FOV: 45 degrees:
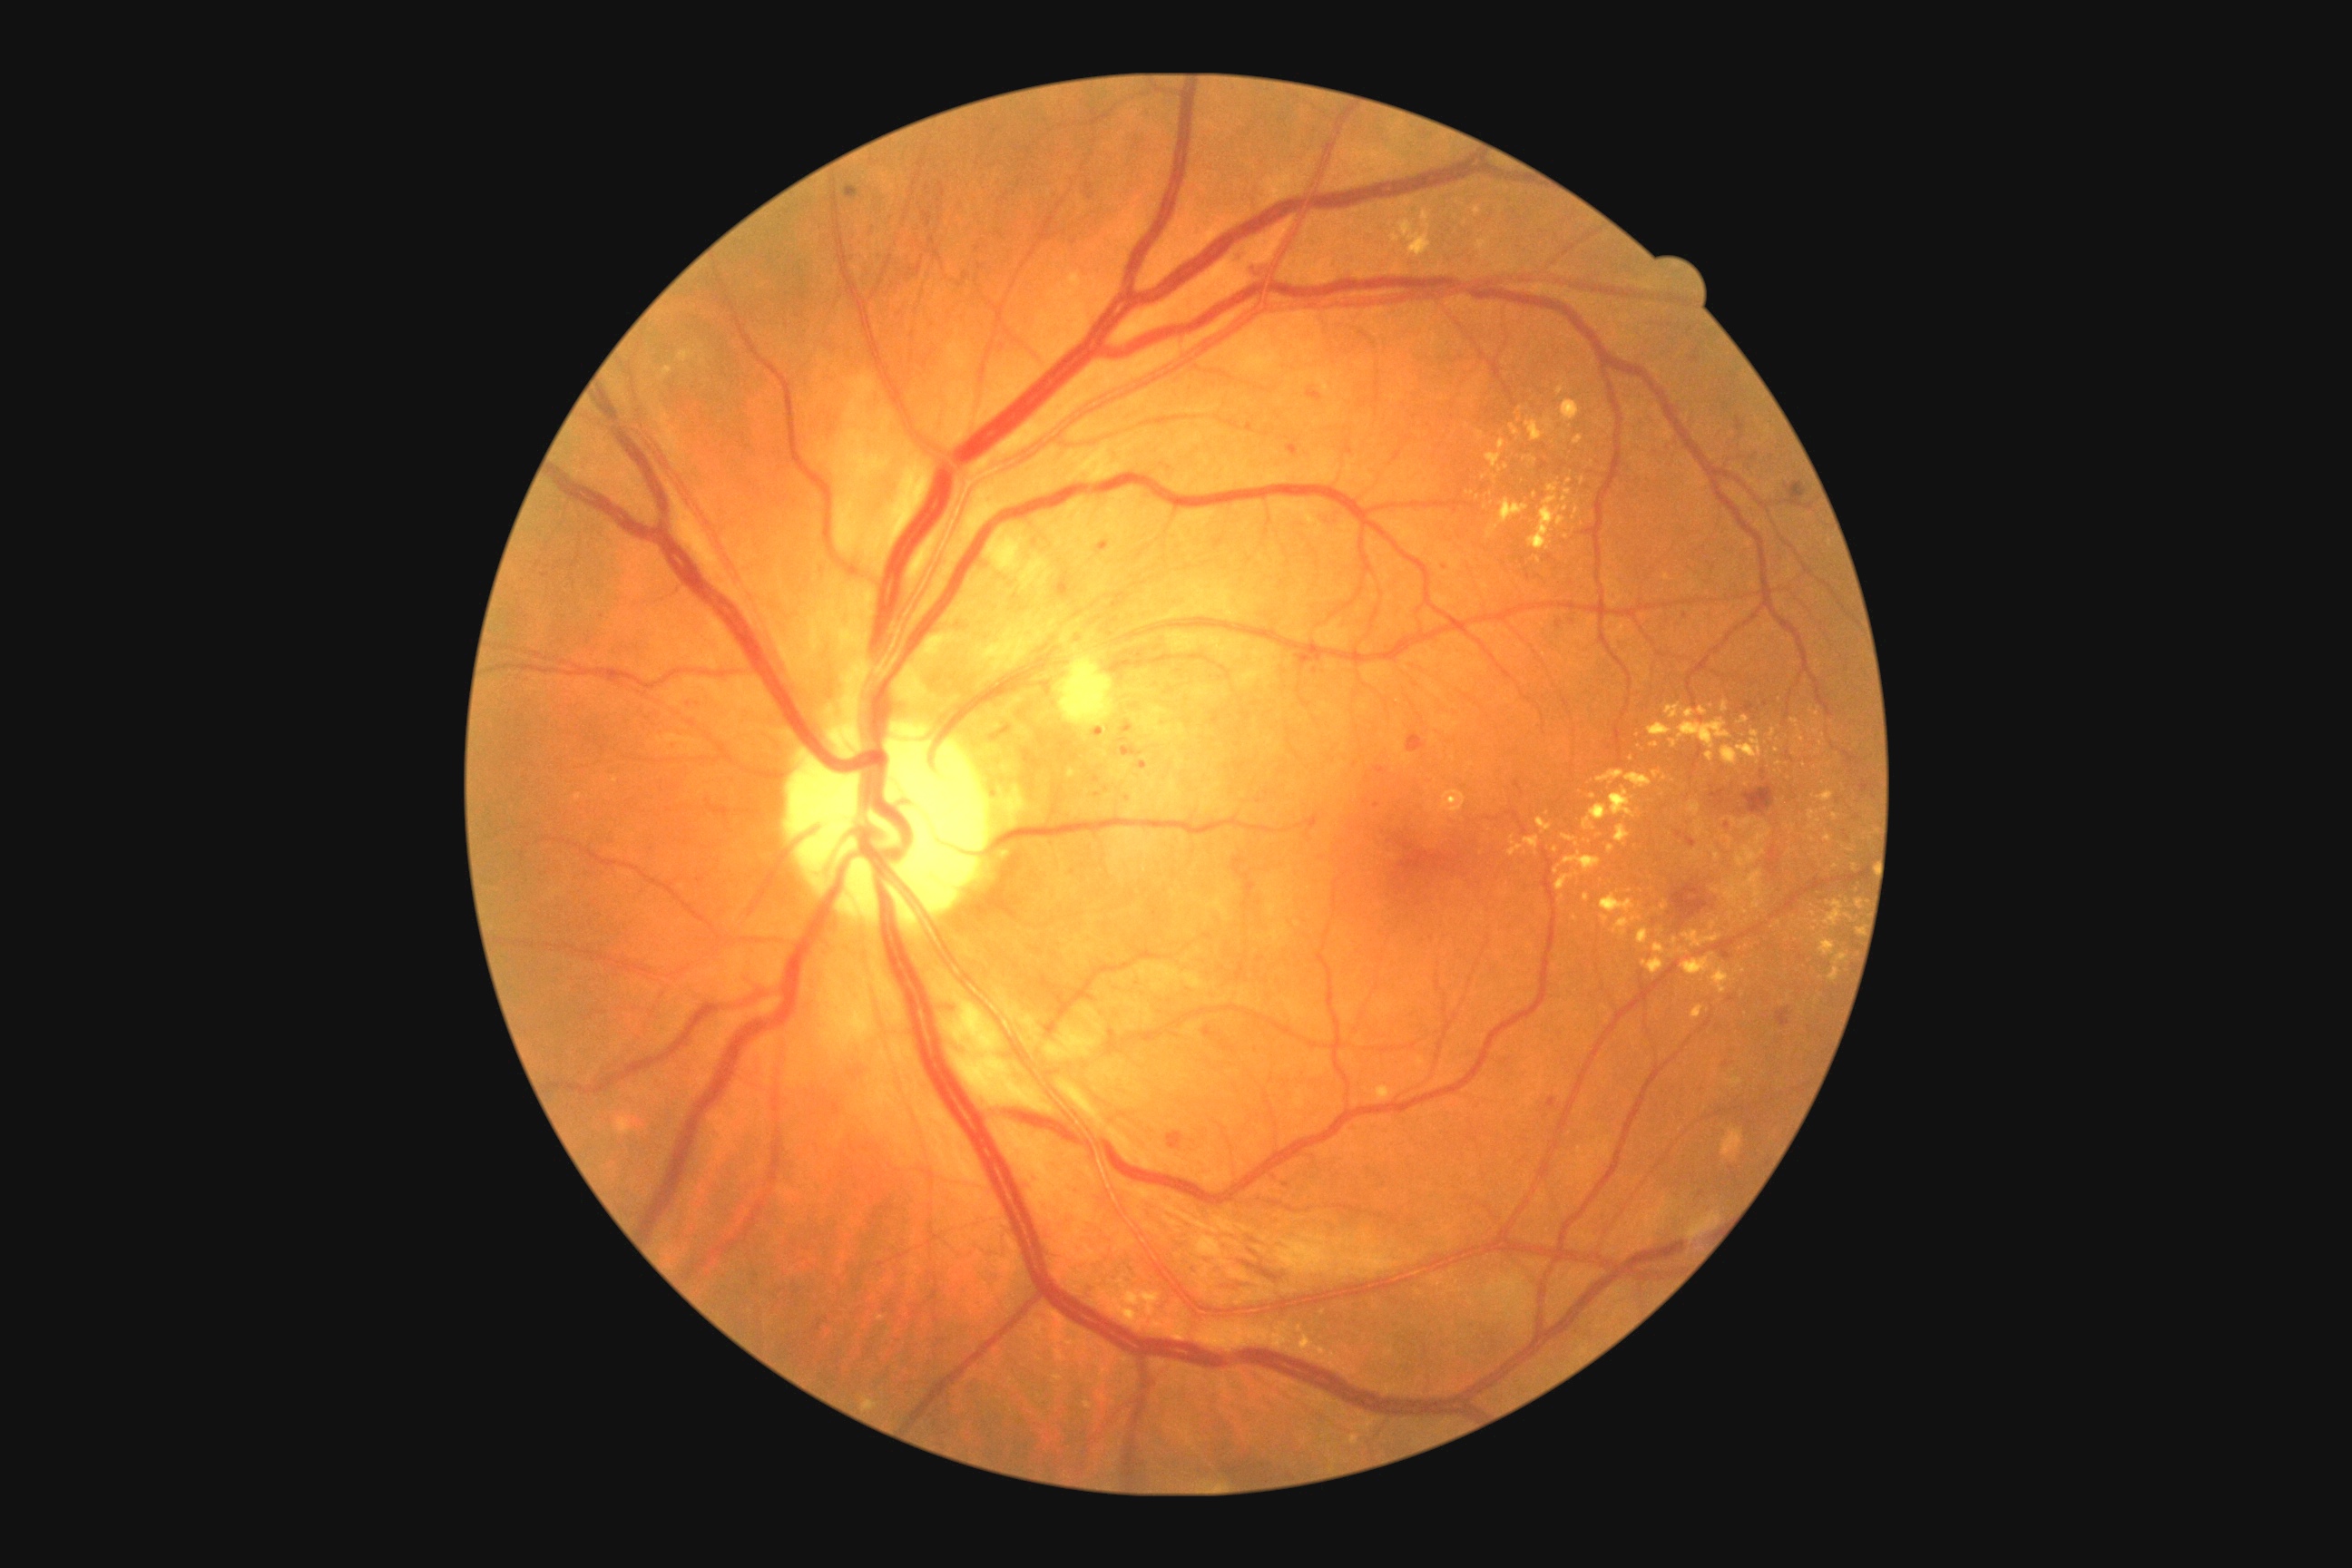 Diabetic retinopathy (DR): grade 2 (moderate NPDR).